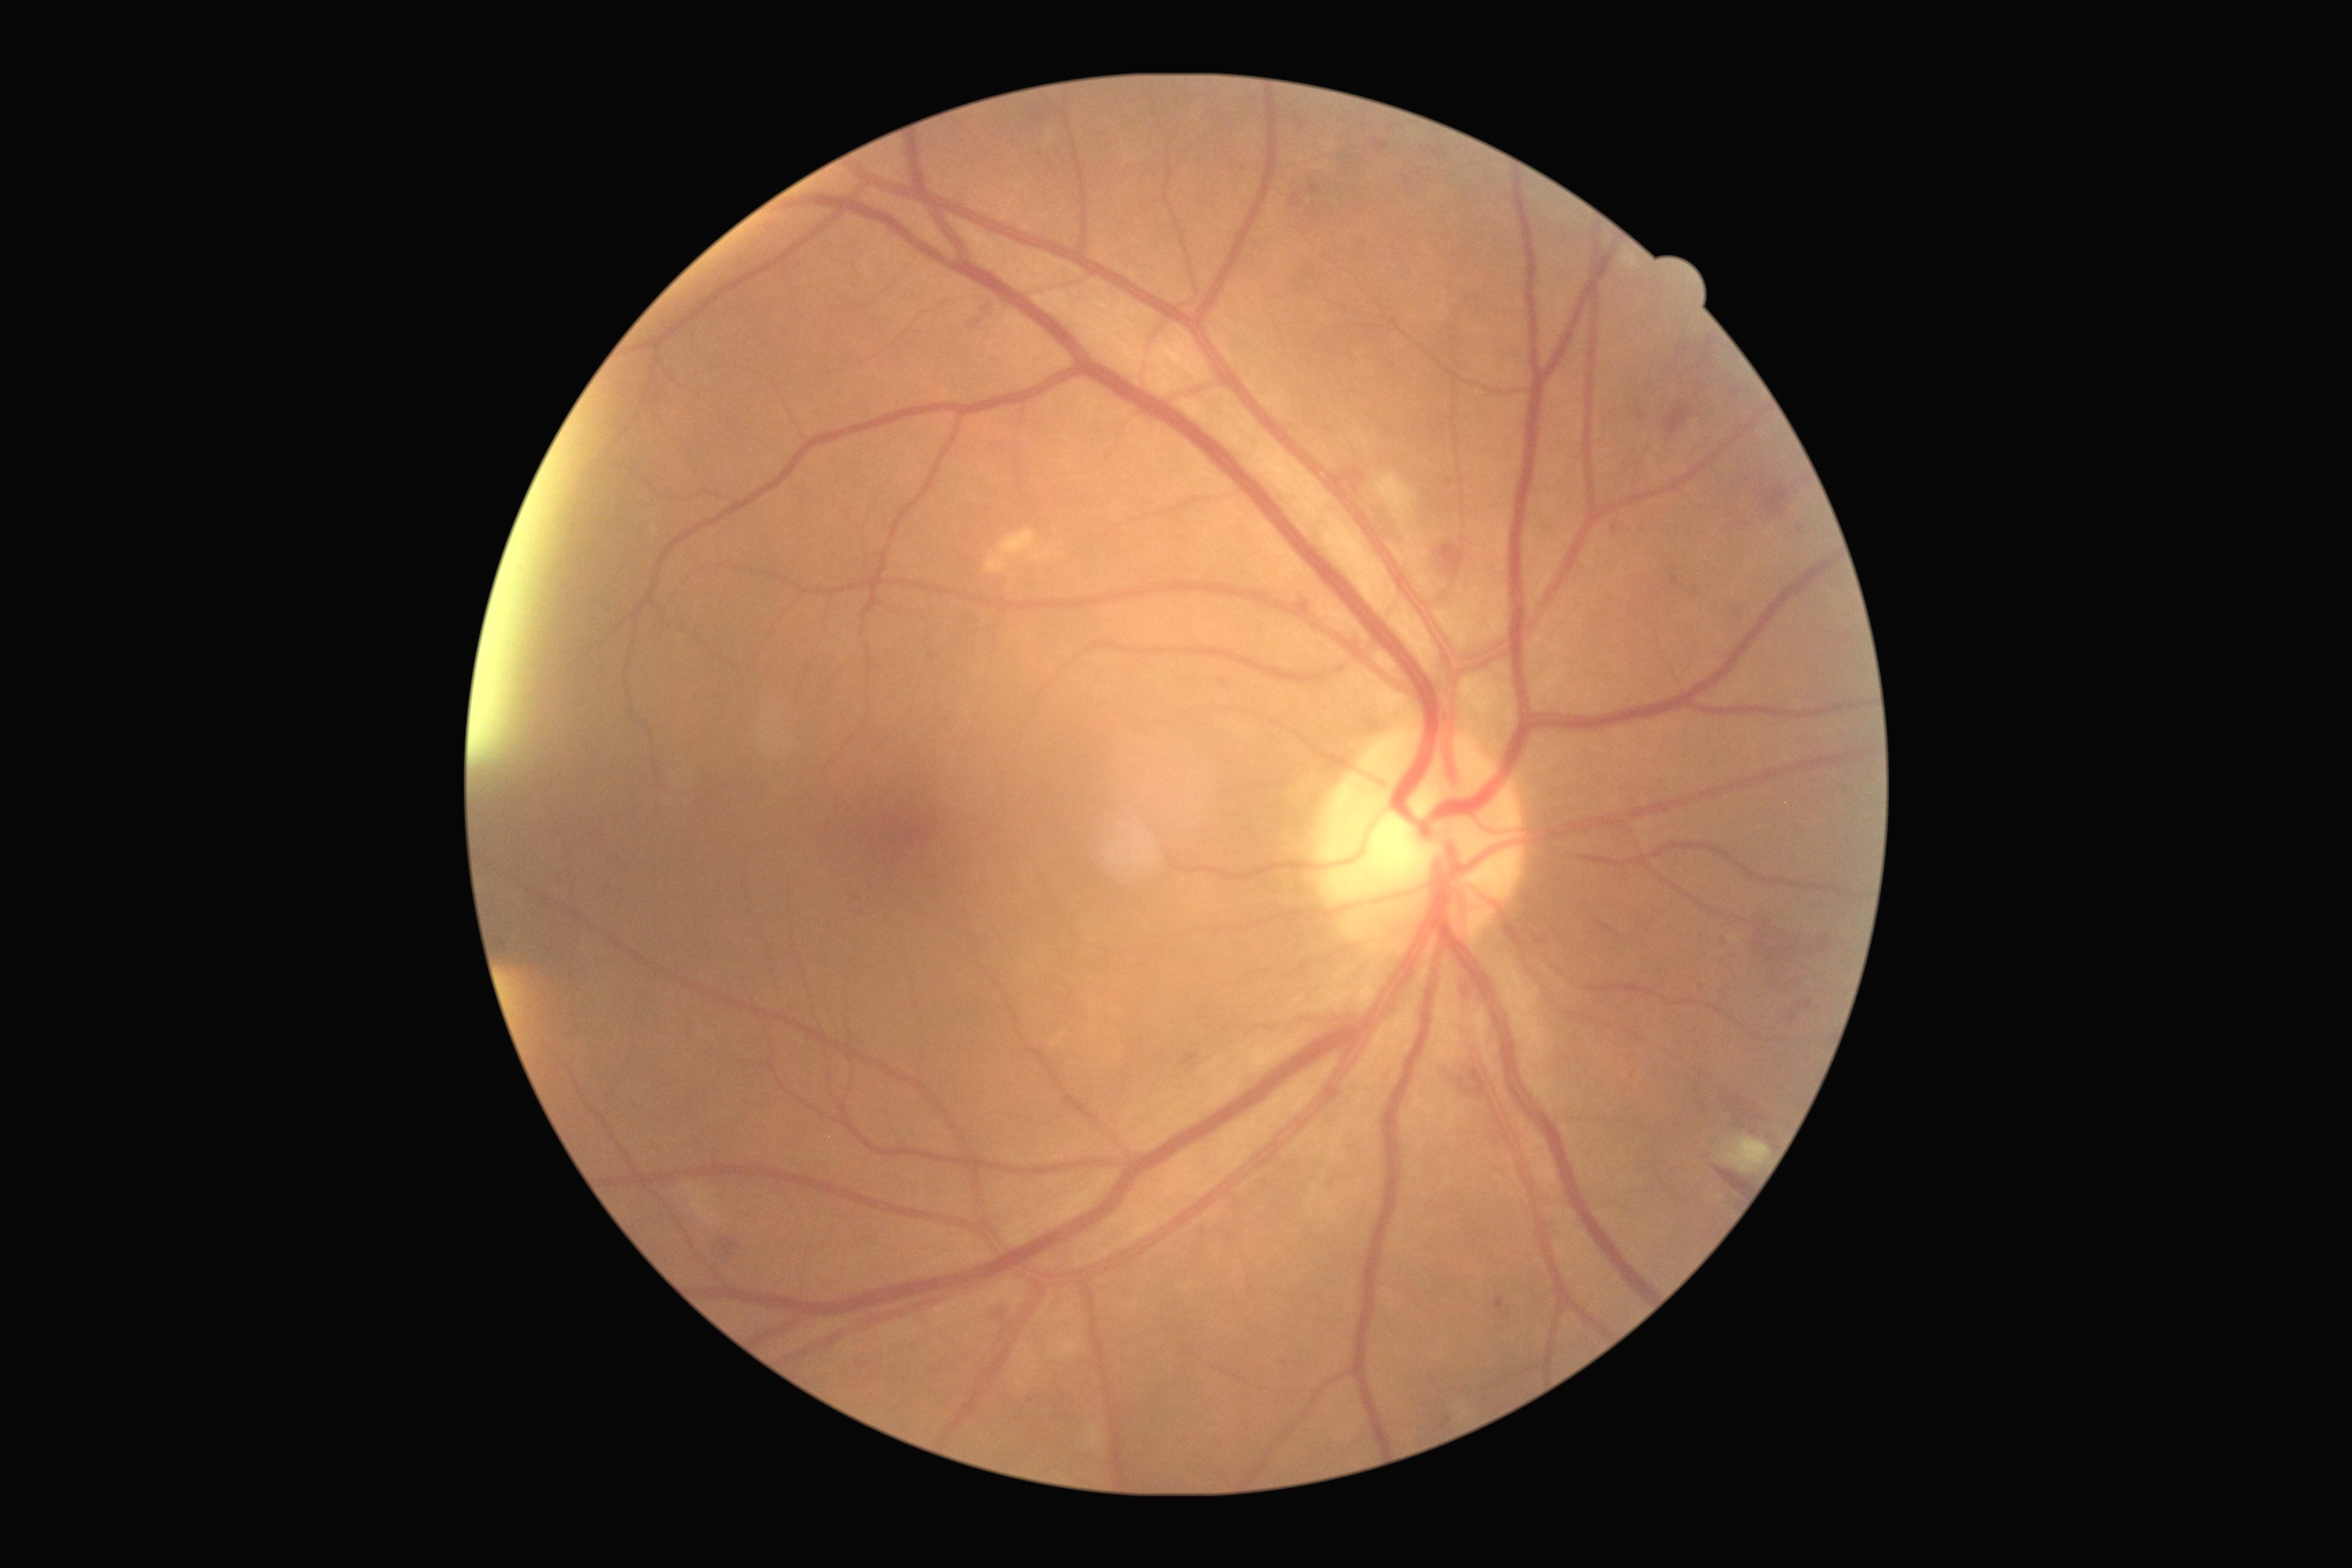
dr_grade: moderate non-proliferative diabetic retinopathy (2)
dr_category: non-proliferative diabetic retinopathy